Fundus photo taken with a portable handheld camera.
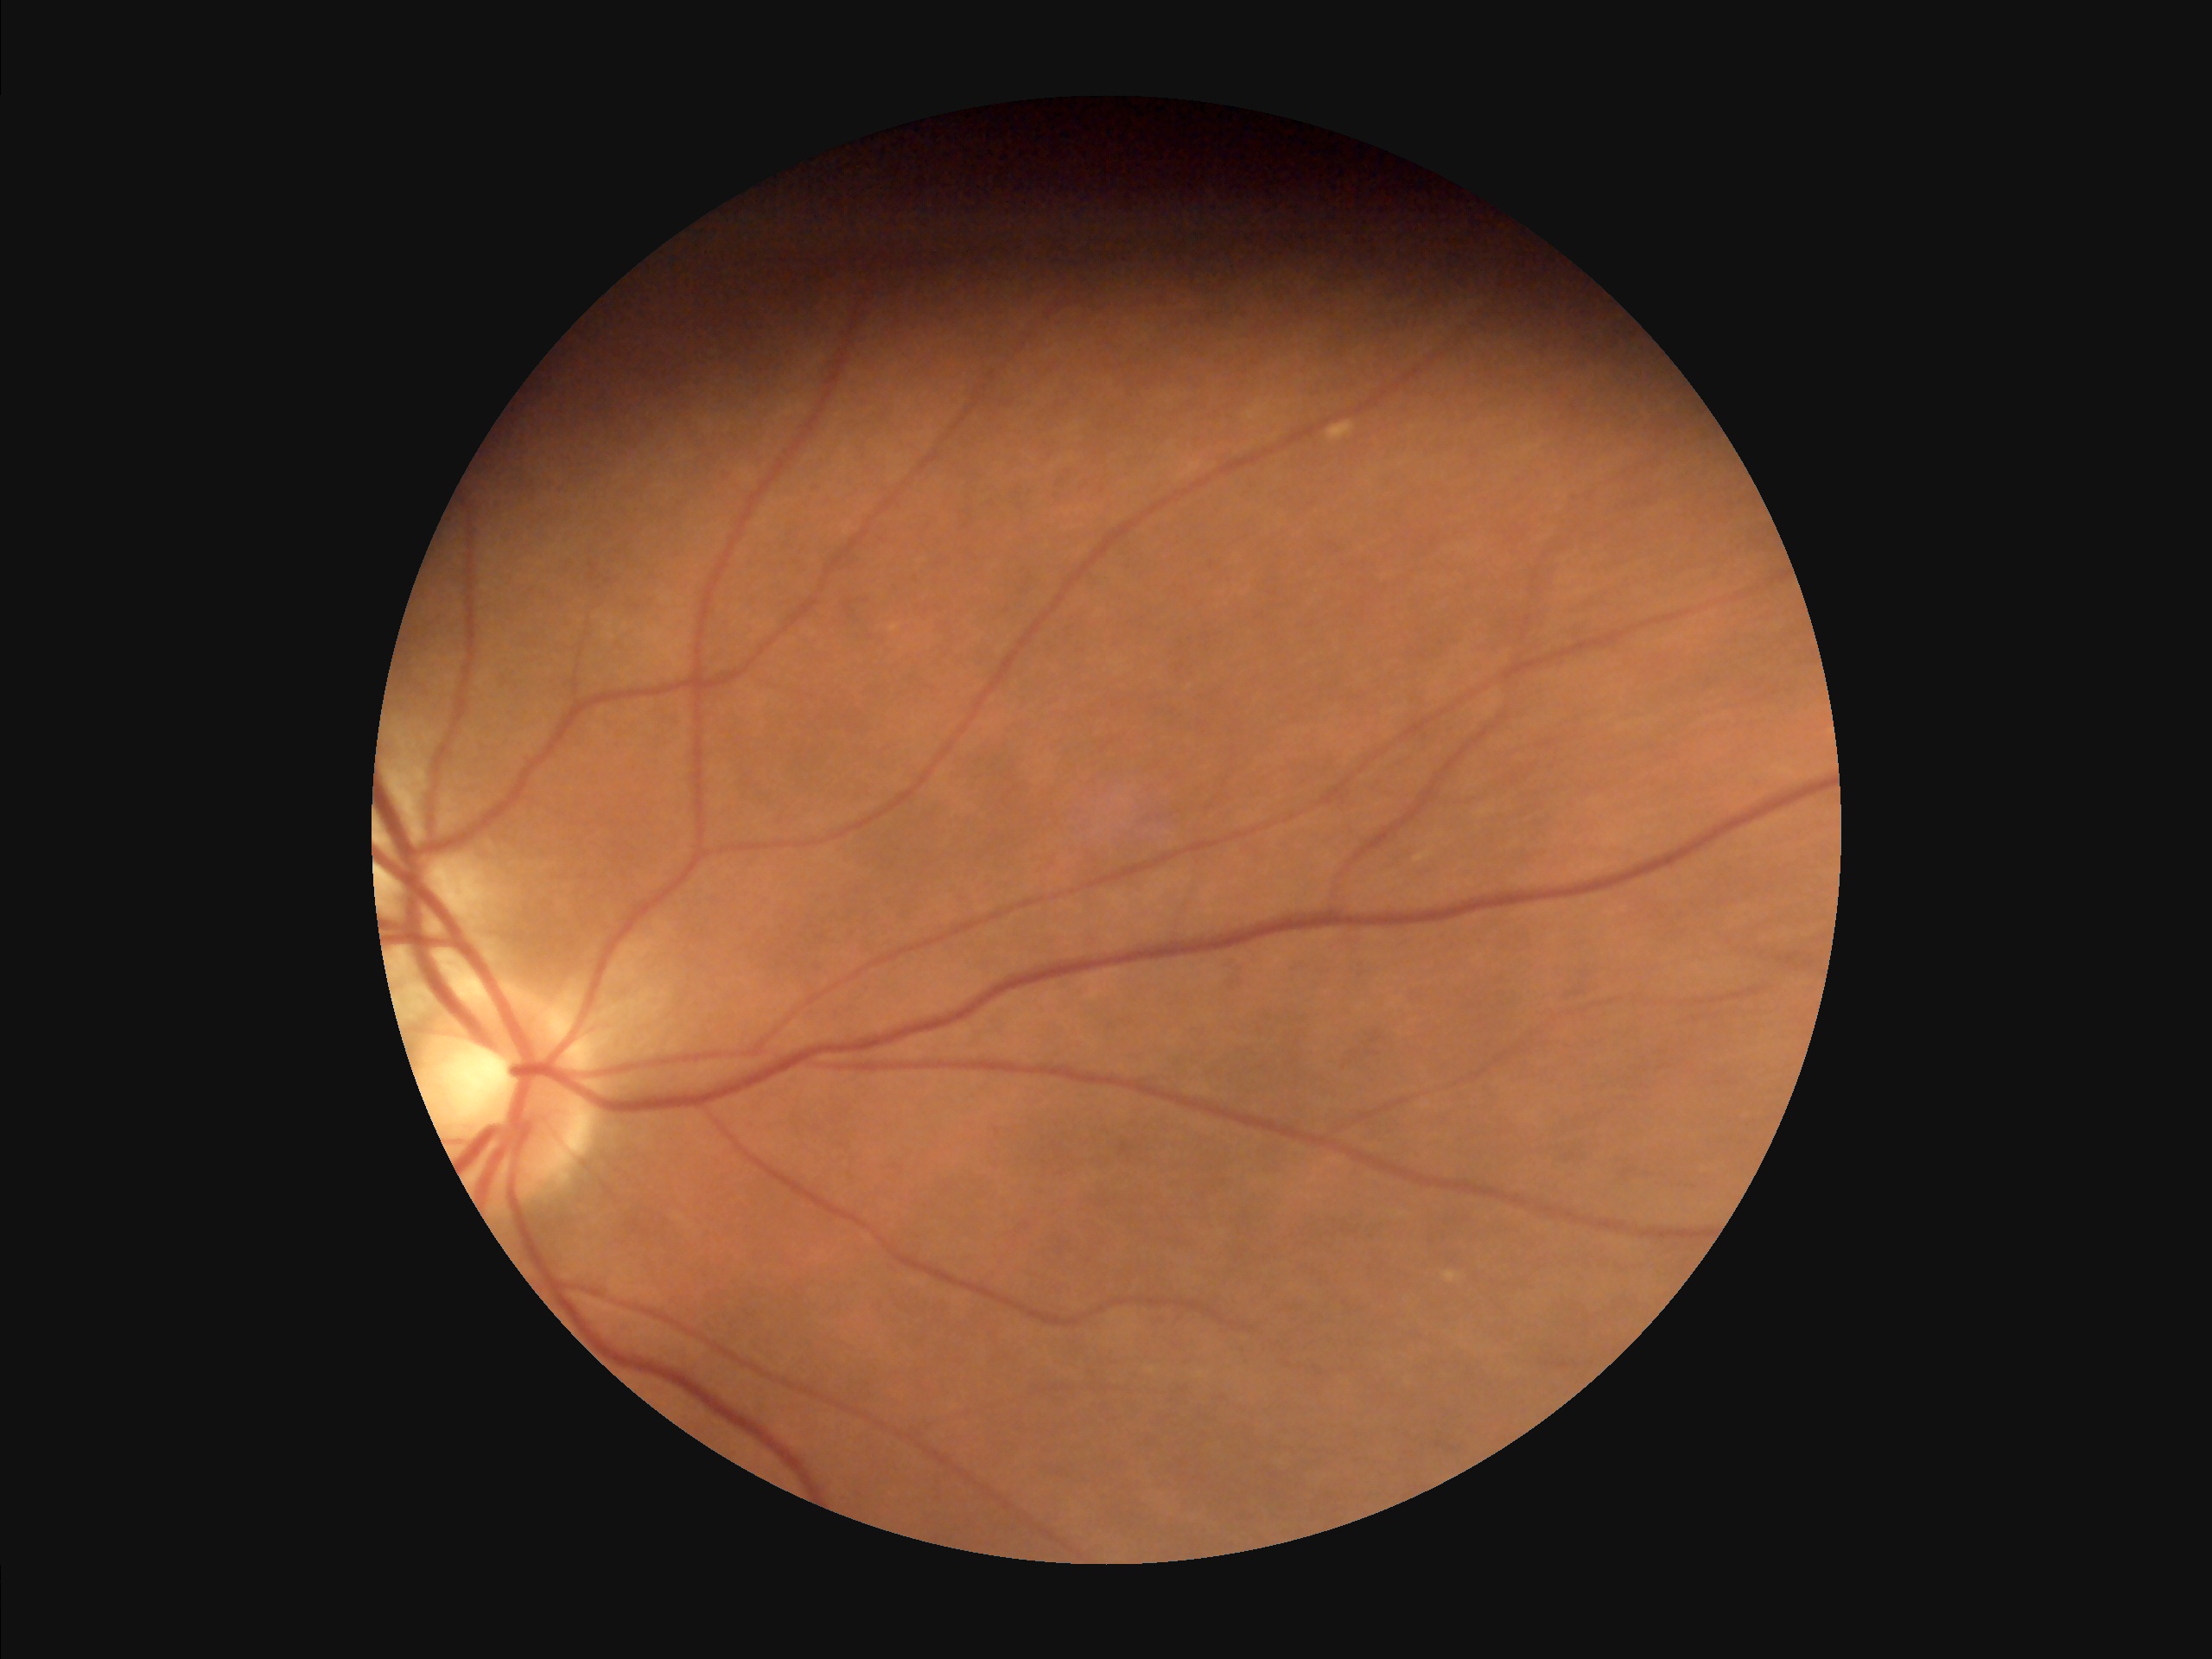 Sharpness = sharp throughout the field | Illumination/color = even and well-balanced | Overall = adequate for clinical interpretation | Contrast = good dynamic range.